Image size 848x848. Diabetic retinopathy graded by the modified Davis classification. Fundus photo:
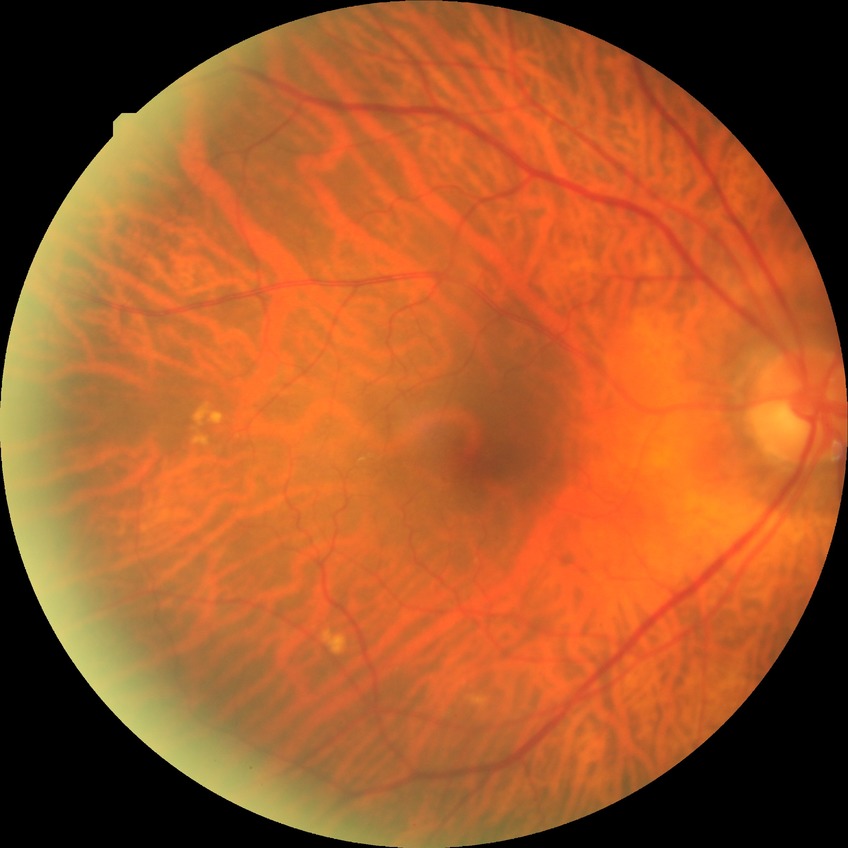
Annotations:
– retinopathy stage — no diabetic retinopathy